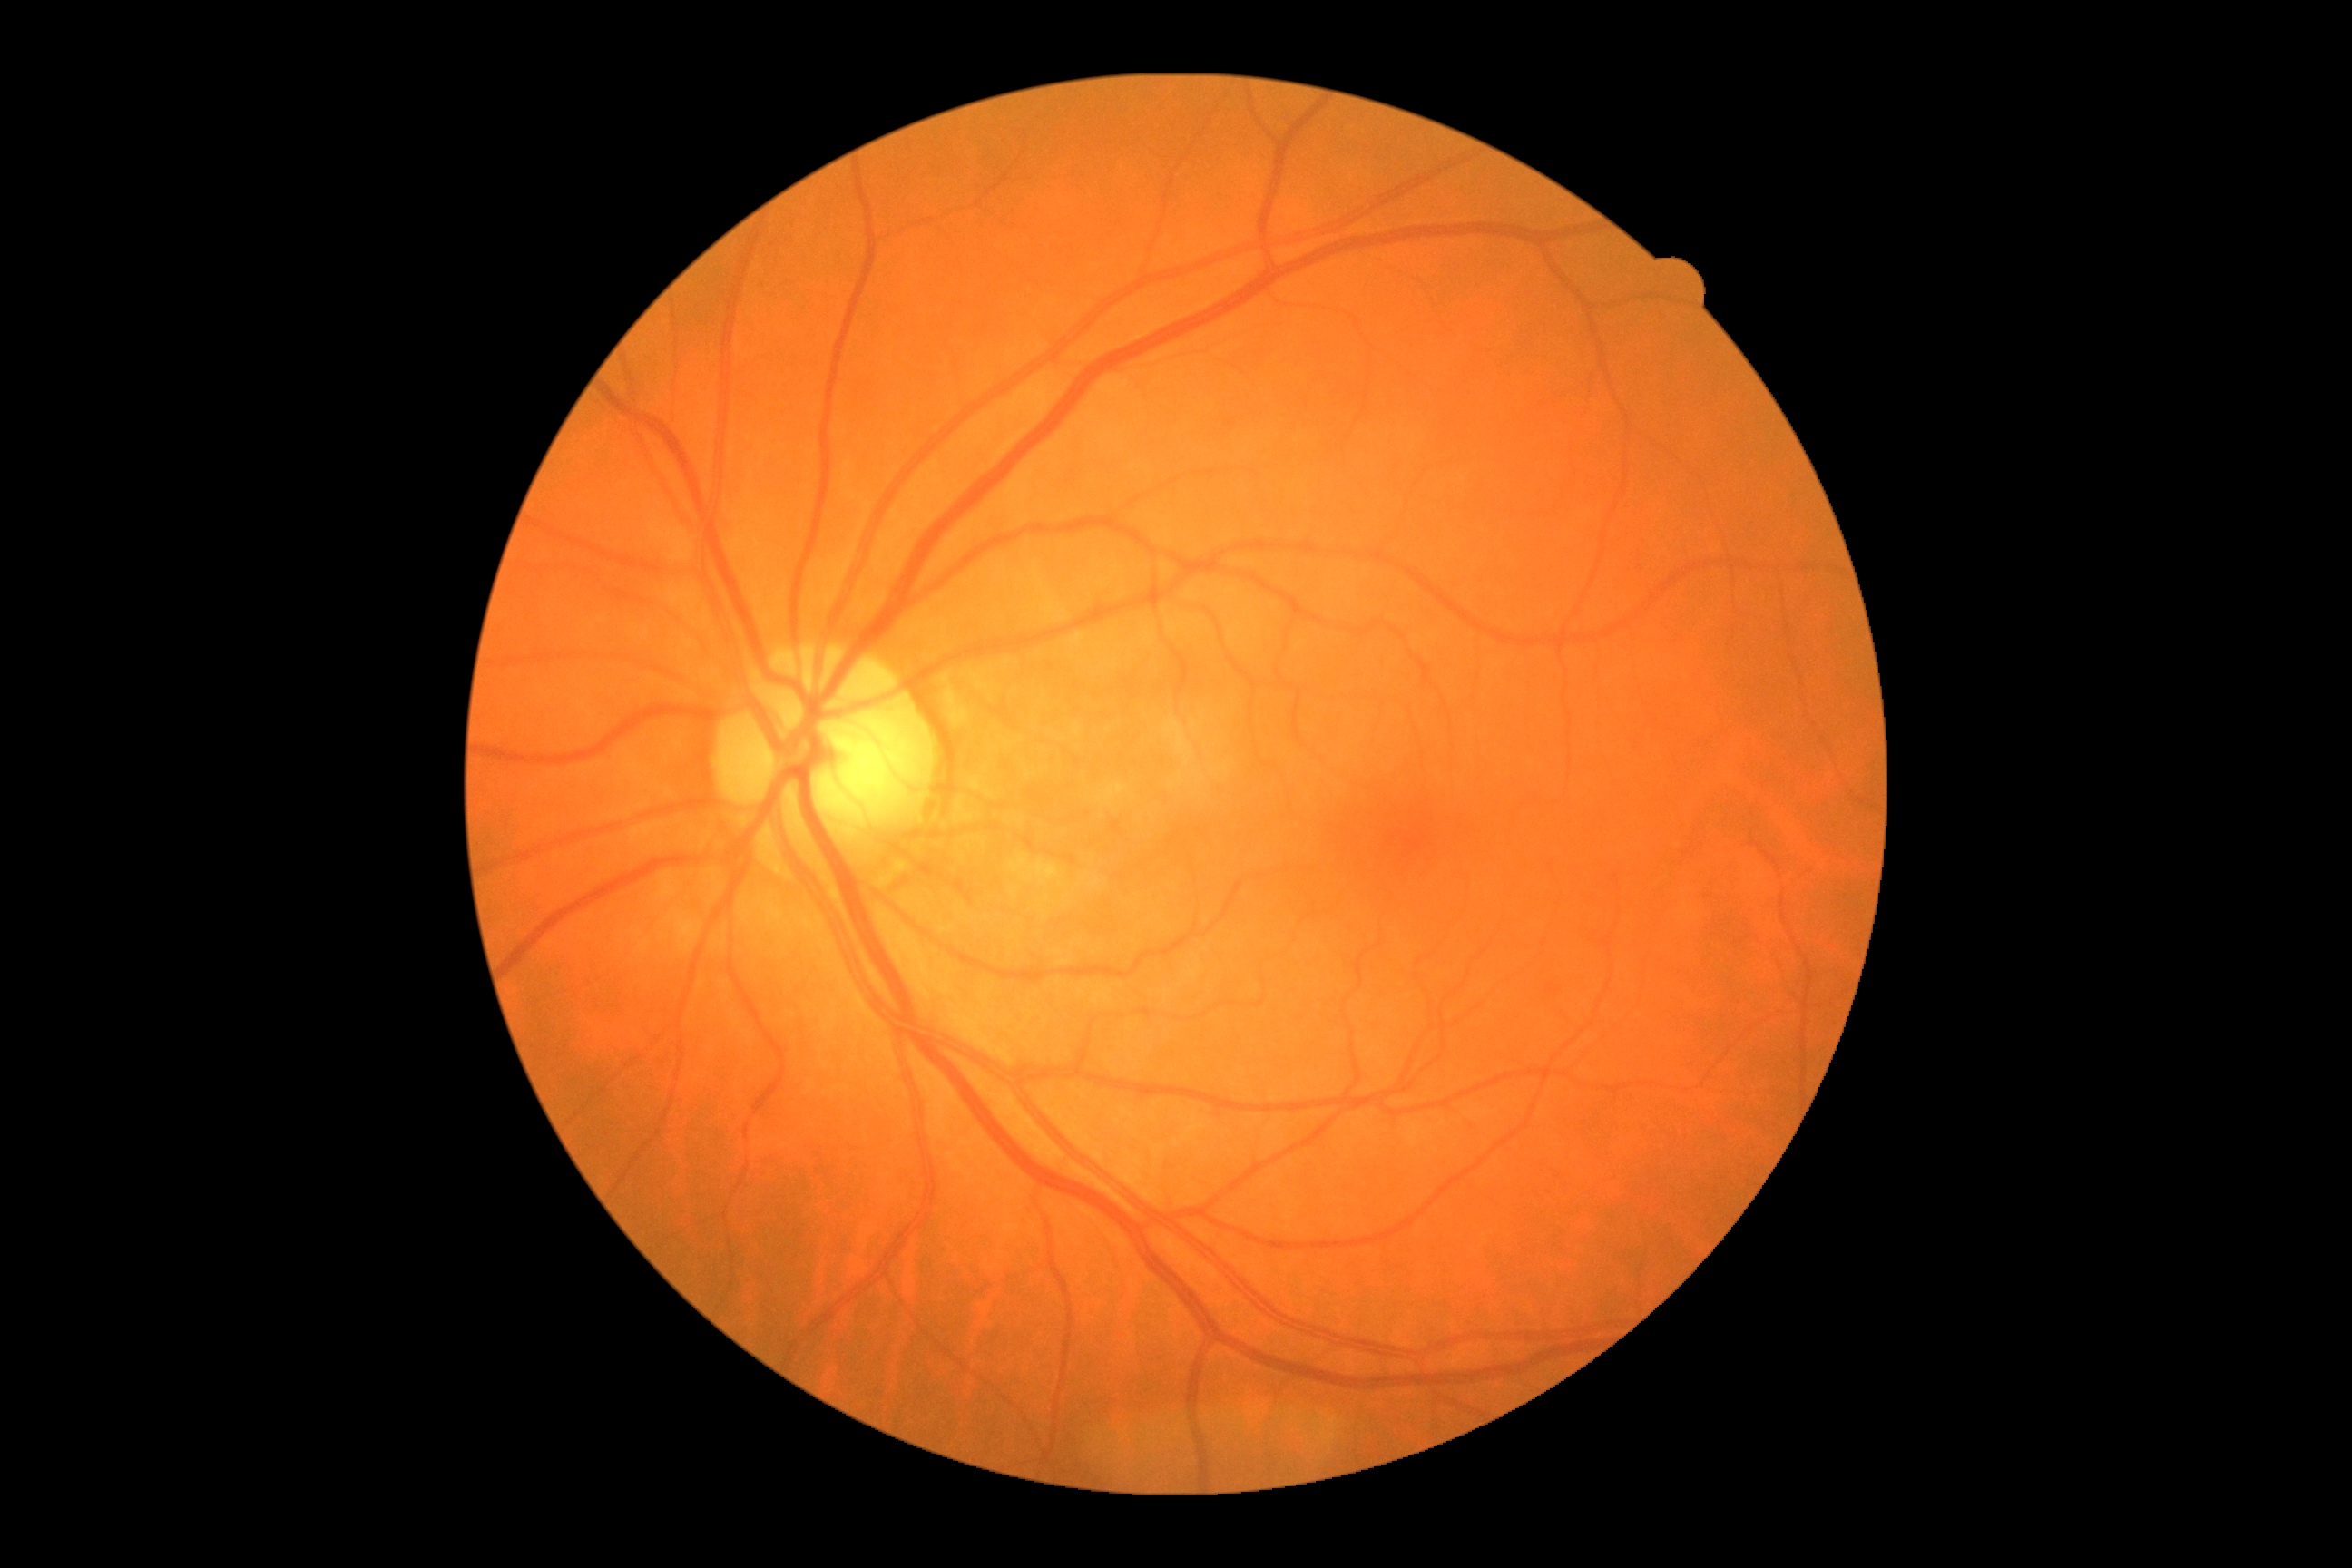 - DR severity — grade 0 (no apparent retinopathy)